848x848px, retinal fundus photograph, 45° FOV.
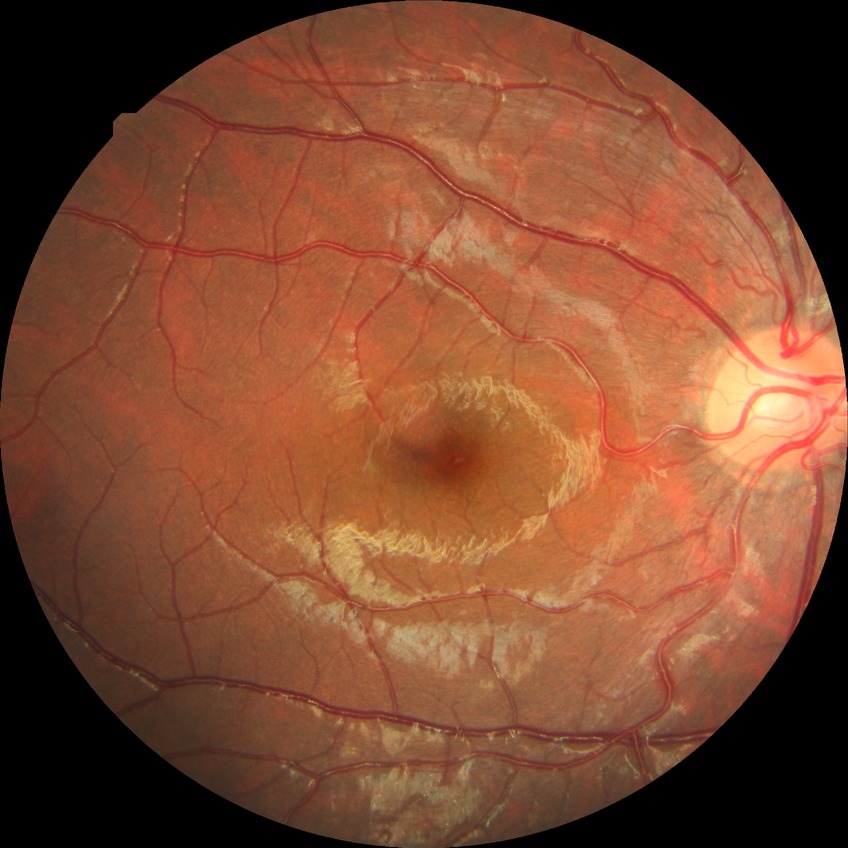 Diabetic retinopathy (DR) is no diabetic retinopathy (NDR).